Topcon TRC-NW8.
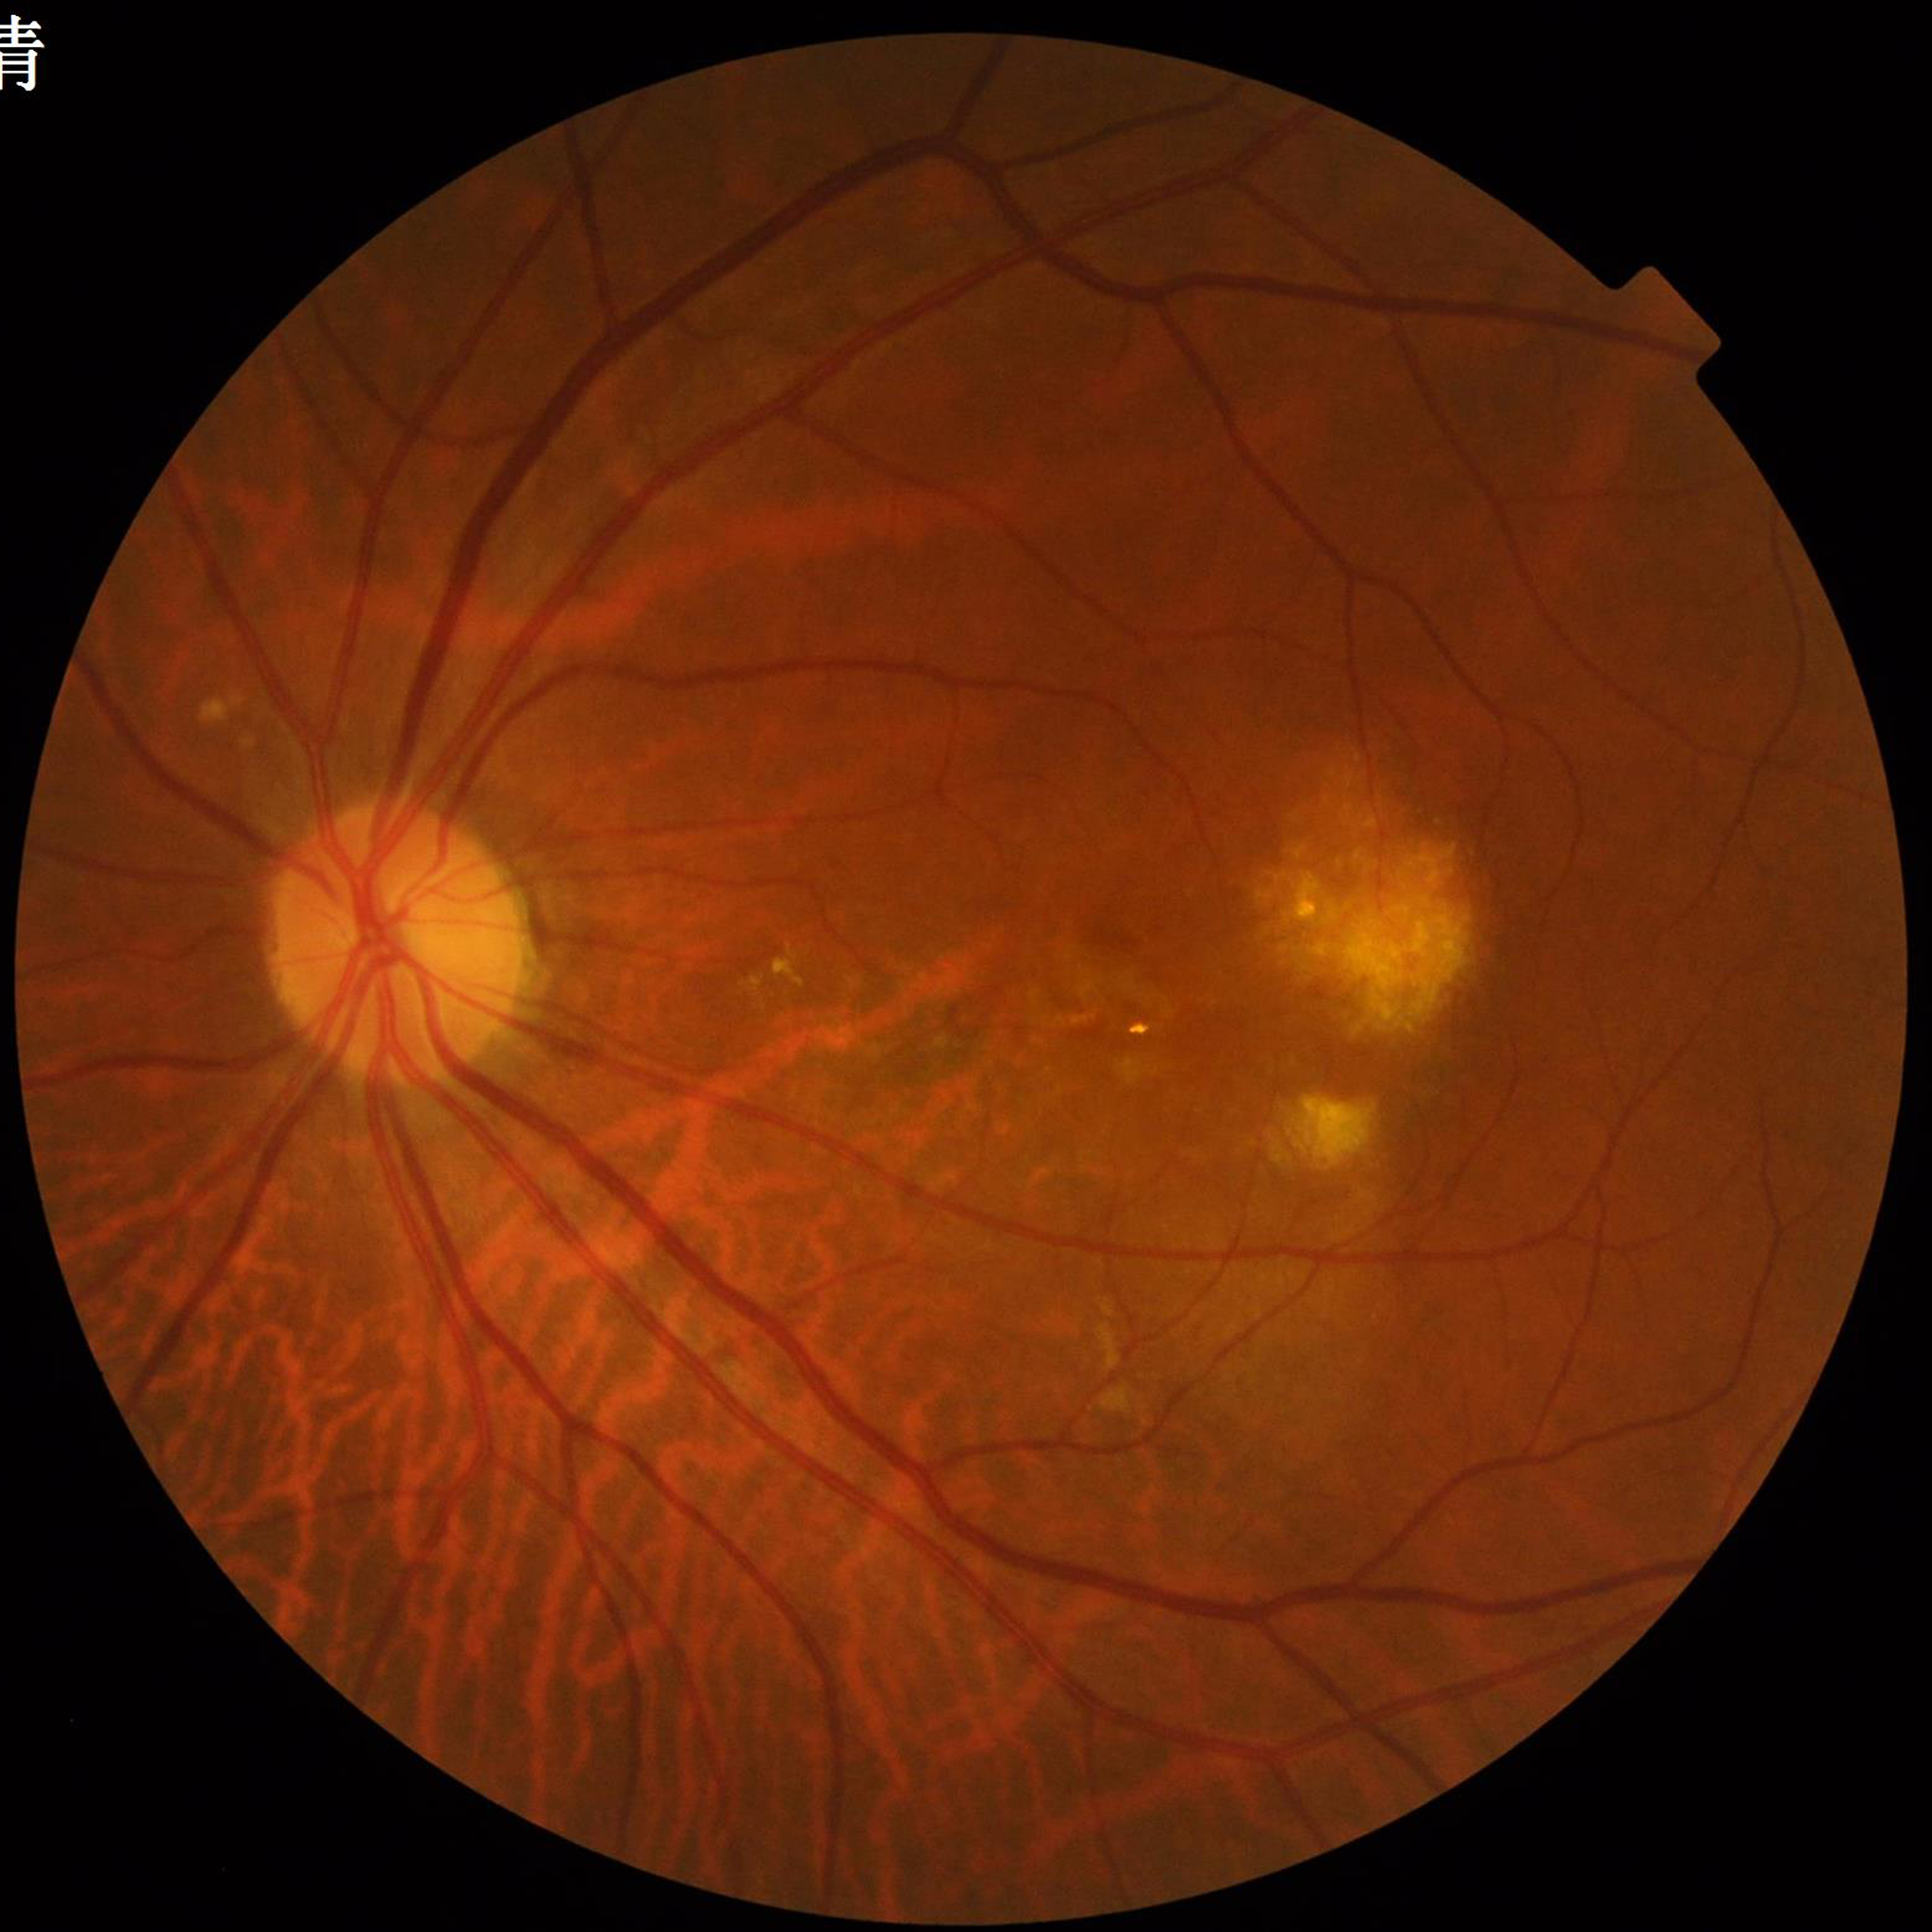
Quality: satisfactory.
Color fundus photograph from a patient diagnosed with AMD.